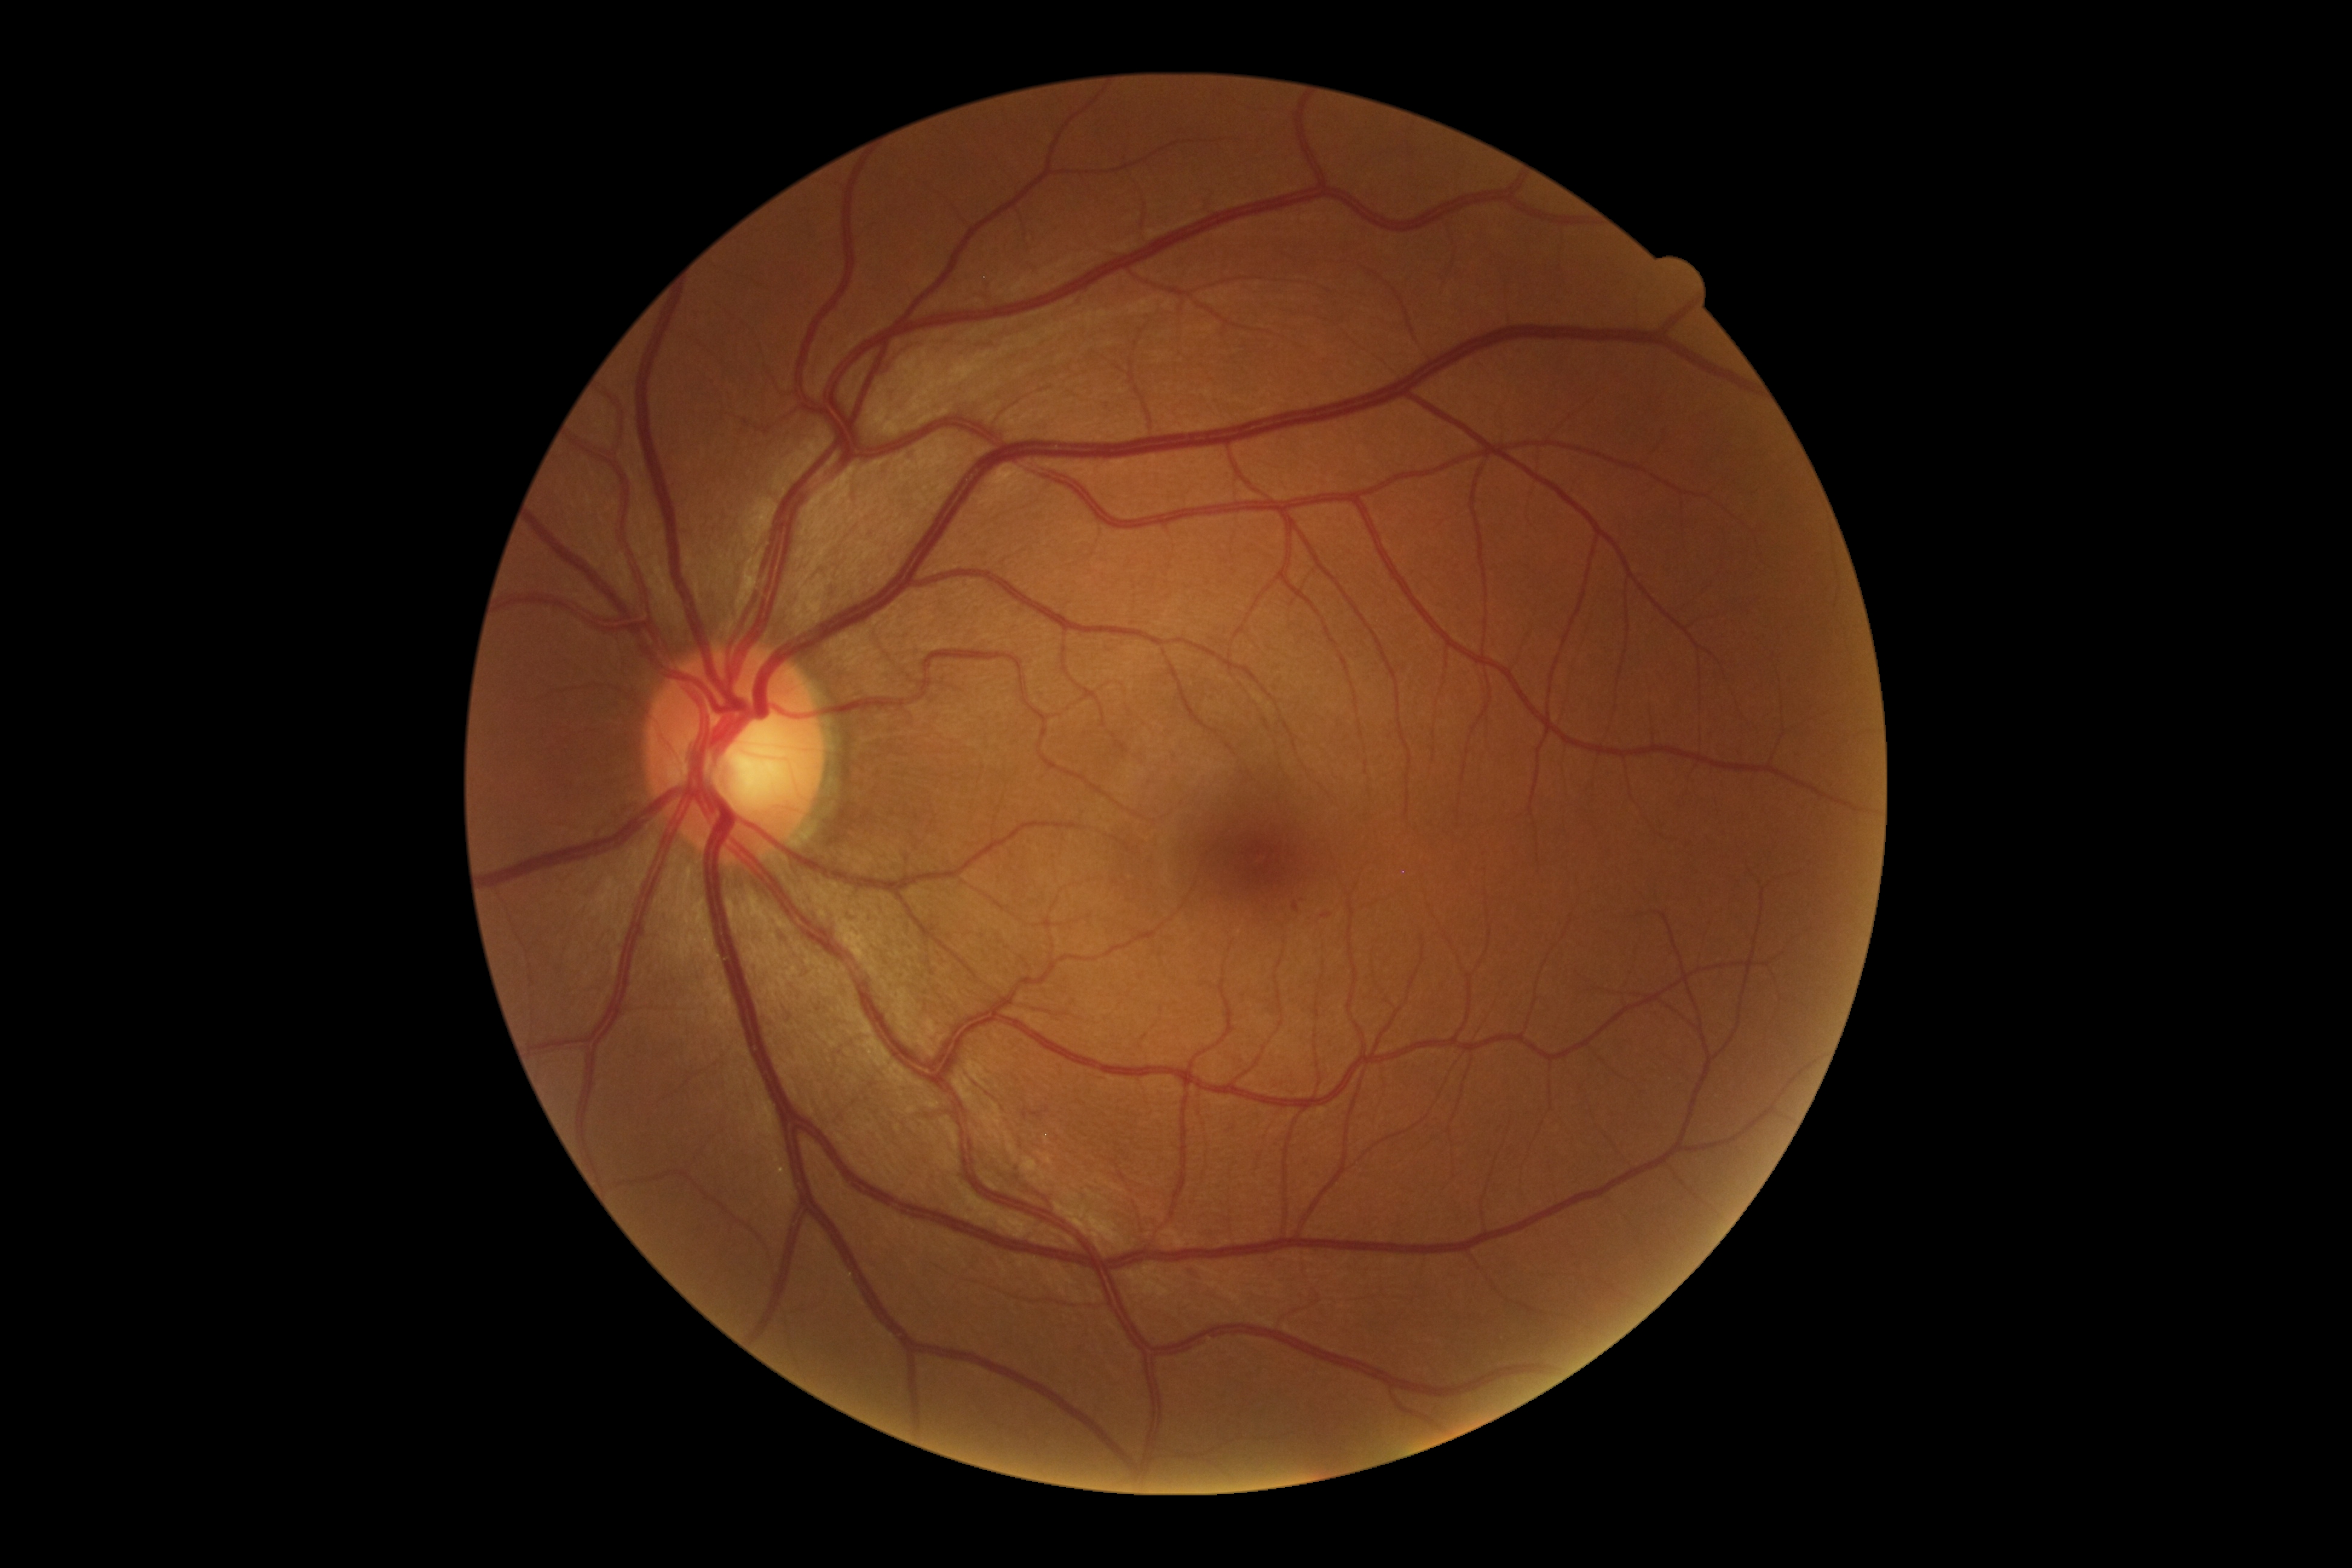

The retinopathy is classified as non-proliferative diabetic retinopathy.
DR severity is grade 1.